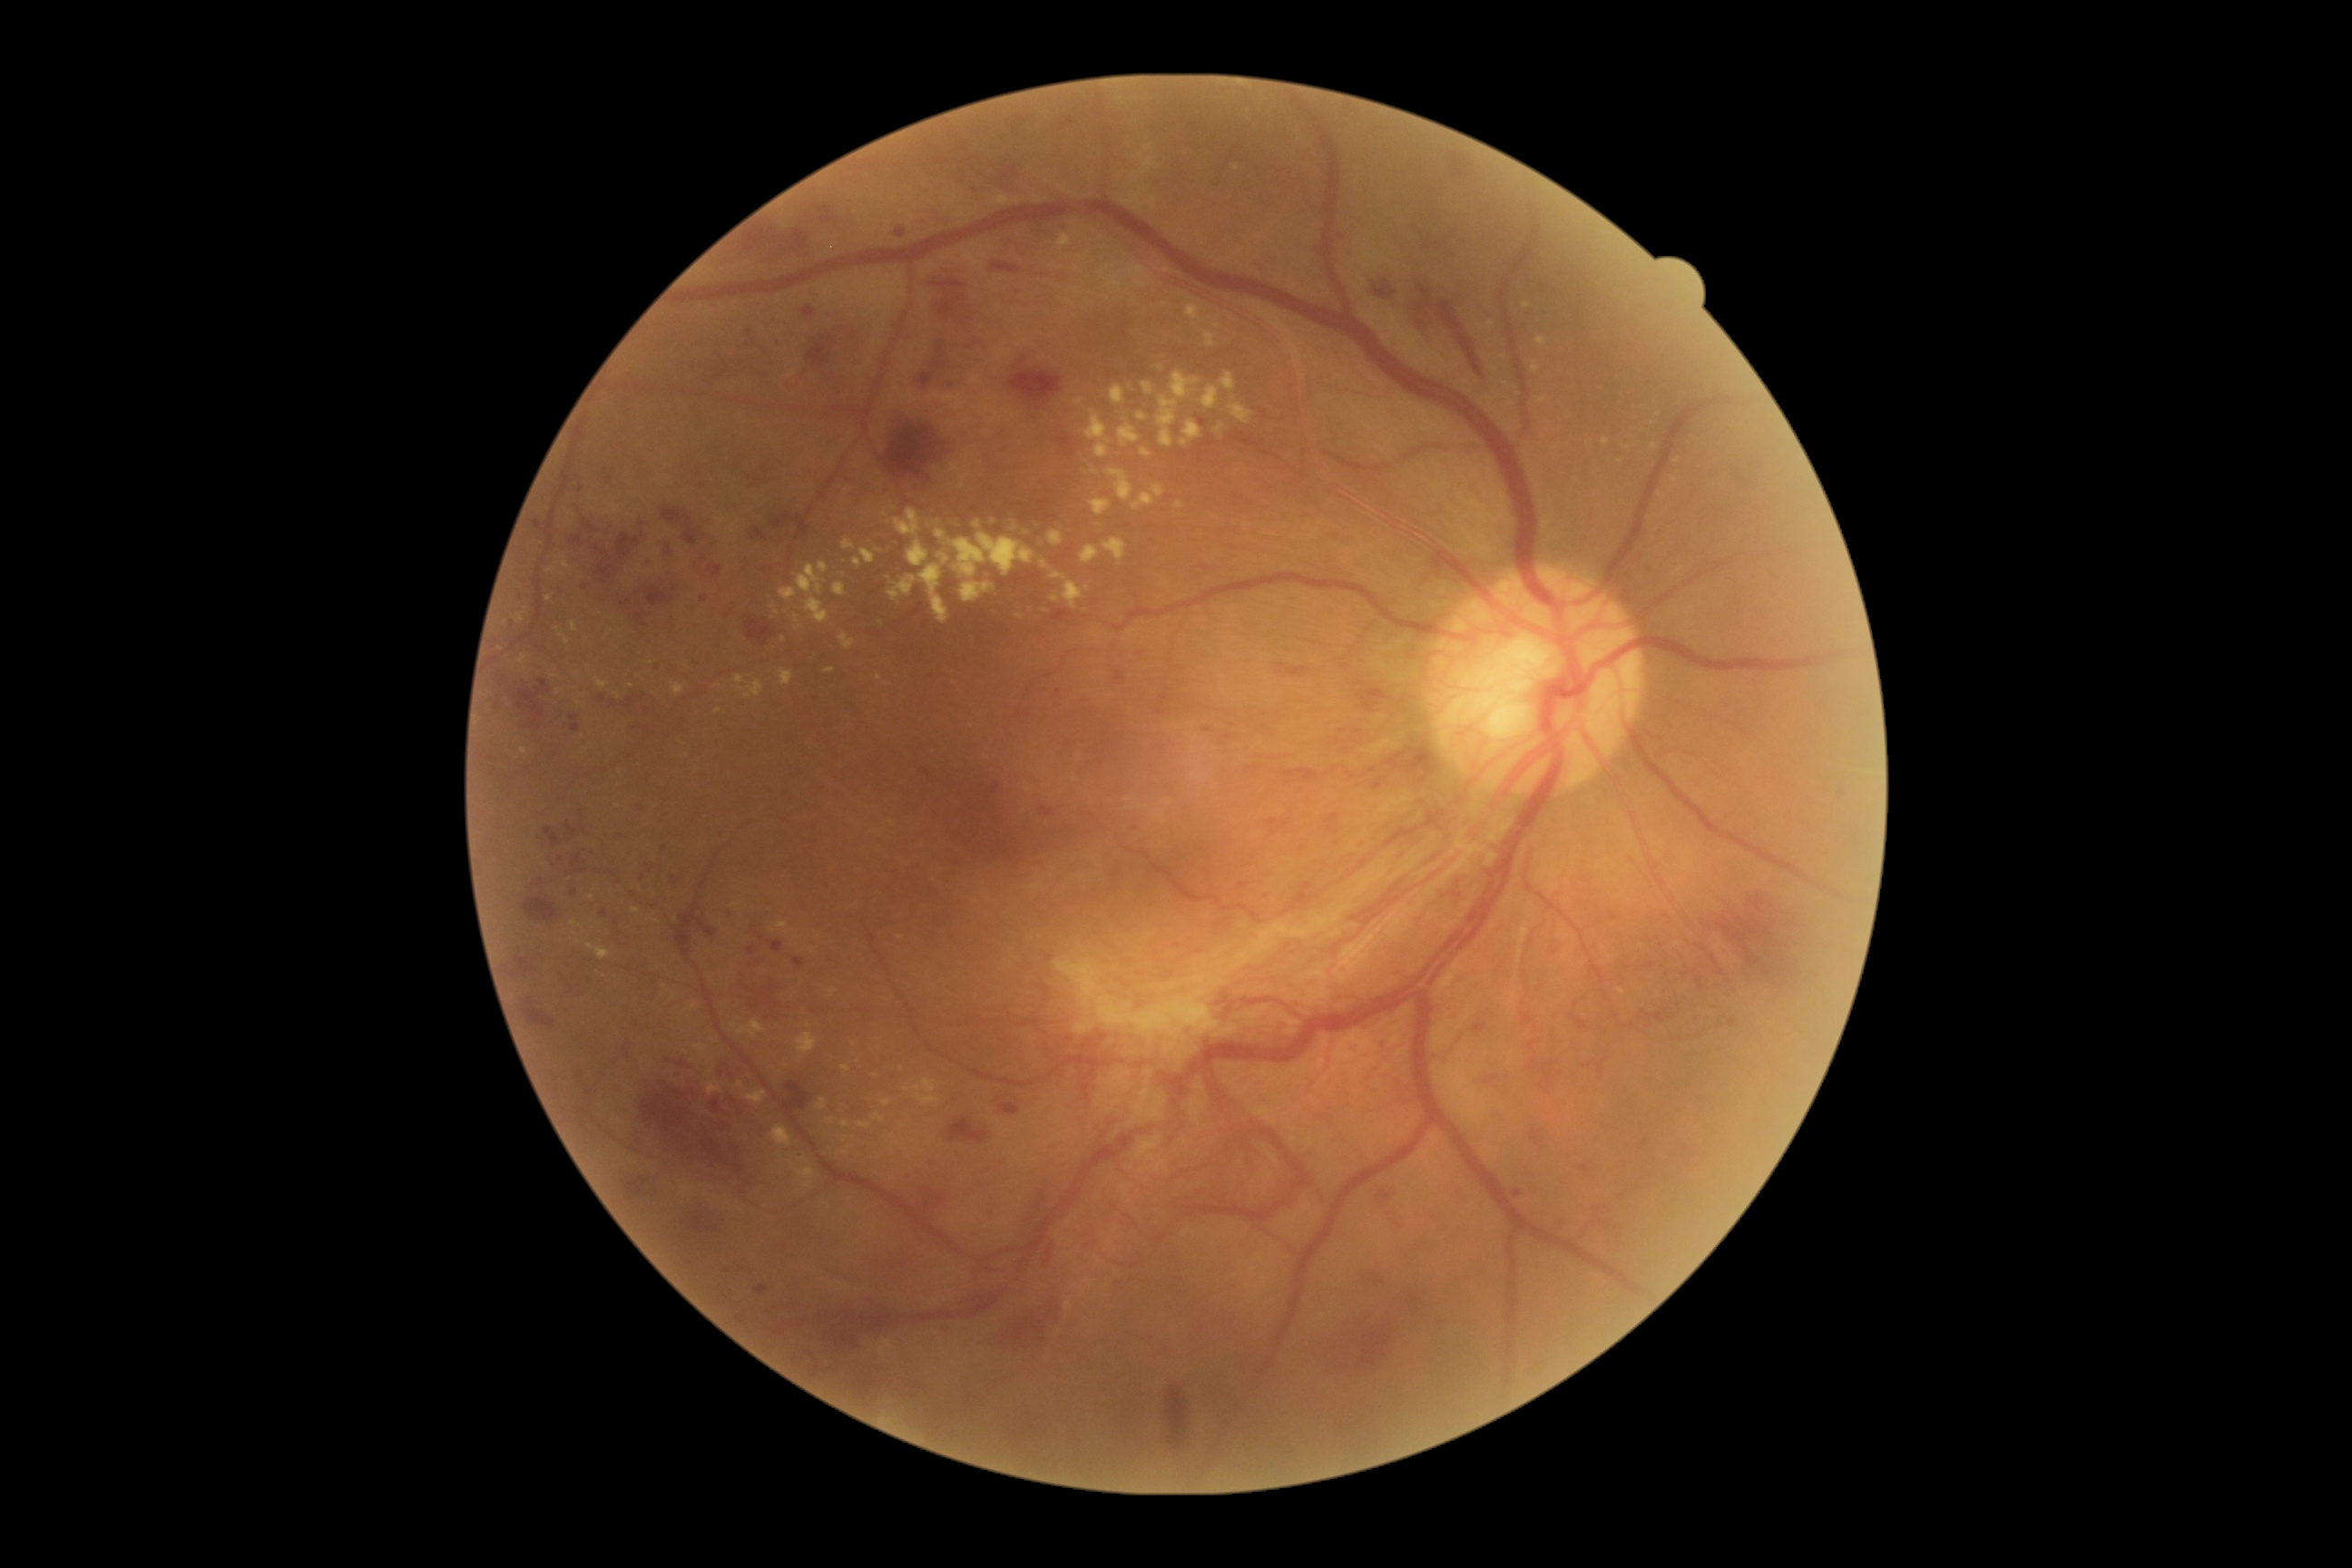

partial: true
dr_grade: 4
dr_grade_name: PDR
lesions:
  ex:
    - 1536:337:1547:346
    - 1602:438:1611:446
    - 571:622:580:632
    - 841:540:856:549
    - 779:671:794:687
    - 894:511:921:536
    - 636:569:649:574
    - 1090:500:1110:516
    - 1157:373:1200:447
    - 1230:404:1253:424
    - 672:683:685:696
  ex_small_centers:
    - <point>591, 898</point>
    - <point>1654, 447</point>
    - <point>1015, 528</point>
    - <point>723, 522</point>
    - <point>900, 938</point>
    - <point>906, 1090</point>
    - <point>1095, 473</point>
  he:
    - 689:1202:725:1233
    - 992:262:1021:275
    - 914:338:946:389
    - 612:1083:622:1097
    - 718:830:725:838
    - 642:582:676:609
    - 725:908:738:921
    - 1348:1313:1400:1371
    - 1571:1015:1587:1028
    - 1642:1010:1665:1023
    - 1044:1244:1055:1268
    - 912:220:925:226
    - 1480:1075:1505:1084
    - 574:852:583:861
    - 1286:769:1318:783
    - 1367:271:1395:299
    - 583:522:594:531
    - 1409:273:1484:377
  he_small_centers:
    - <point>559, 858</point>
  ma:
    - 1580:1166:1589:1173
    - 749:946:756:956
    - 534:522:542:531
    - 571:723:582:734
    - 643:558:654:569
    - 756:1286:769:1295
    - 1240:885:1248:888
    - 618:1084:627:1088
  ma_small_centers:
    - <point>1071, 122</point>
    - <point>951, 384</point>
    - <point>1341, 237</point>
    - <point>1051, 959</point>
    - <point>643, 525</point>
    - <point>1137, 828</point>
    - <point>574, 718</point>